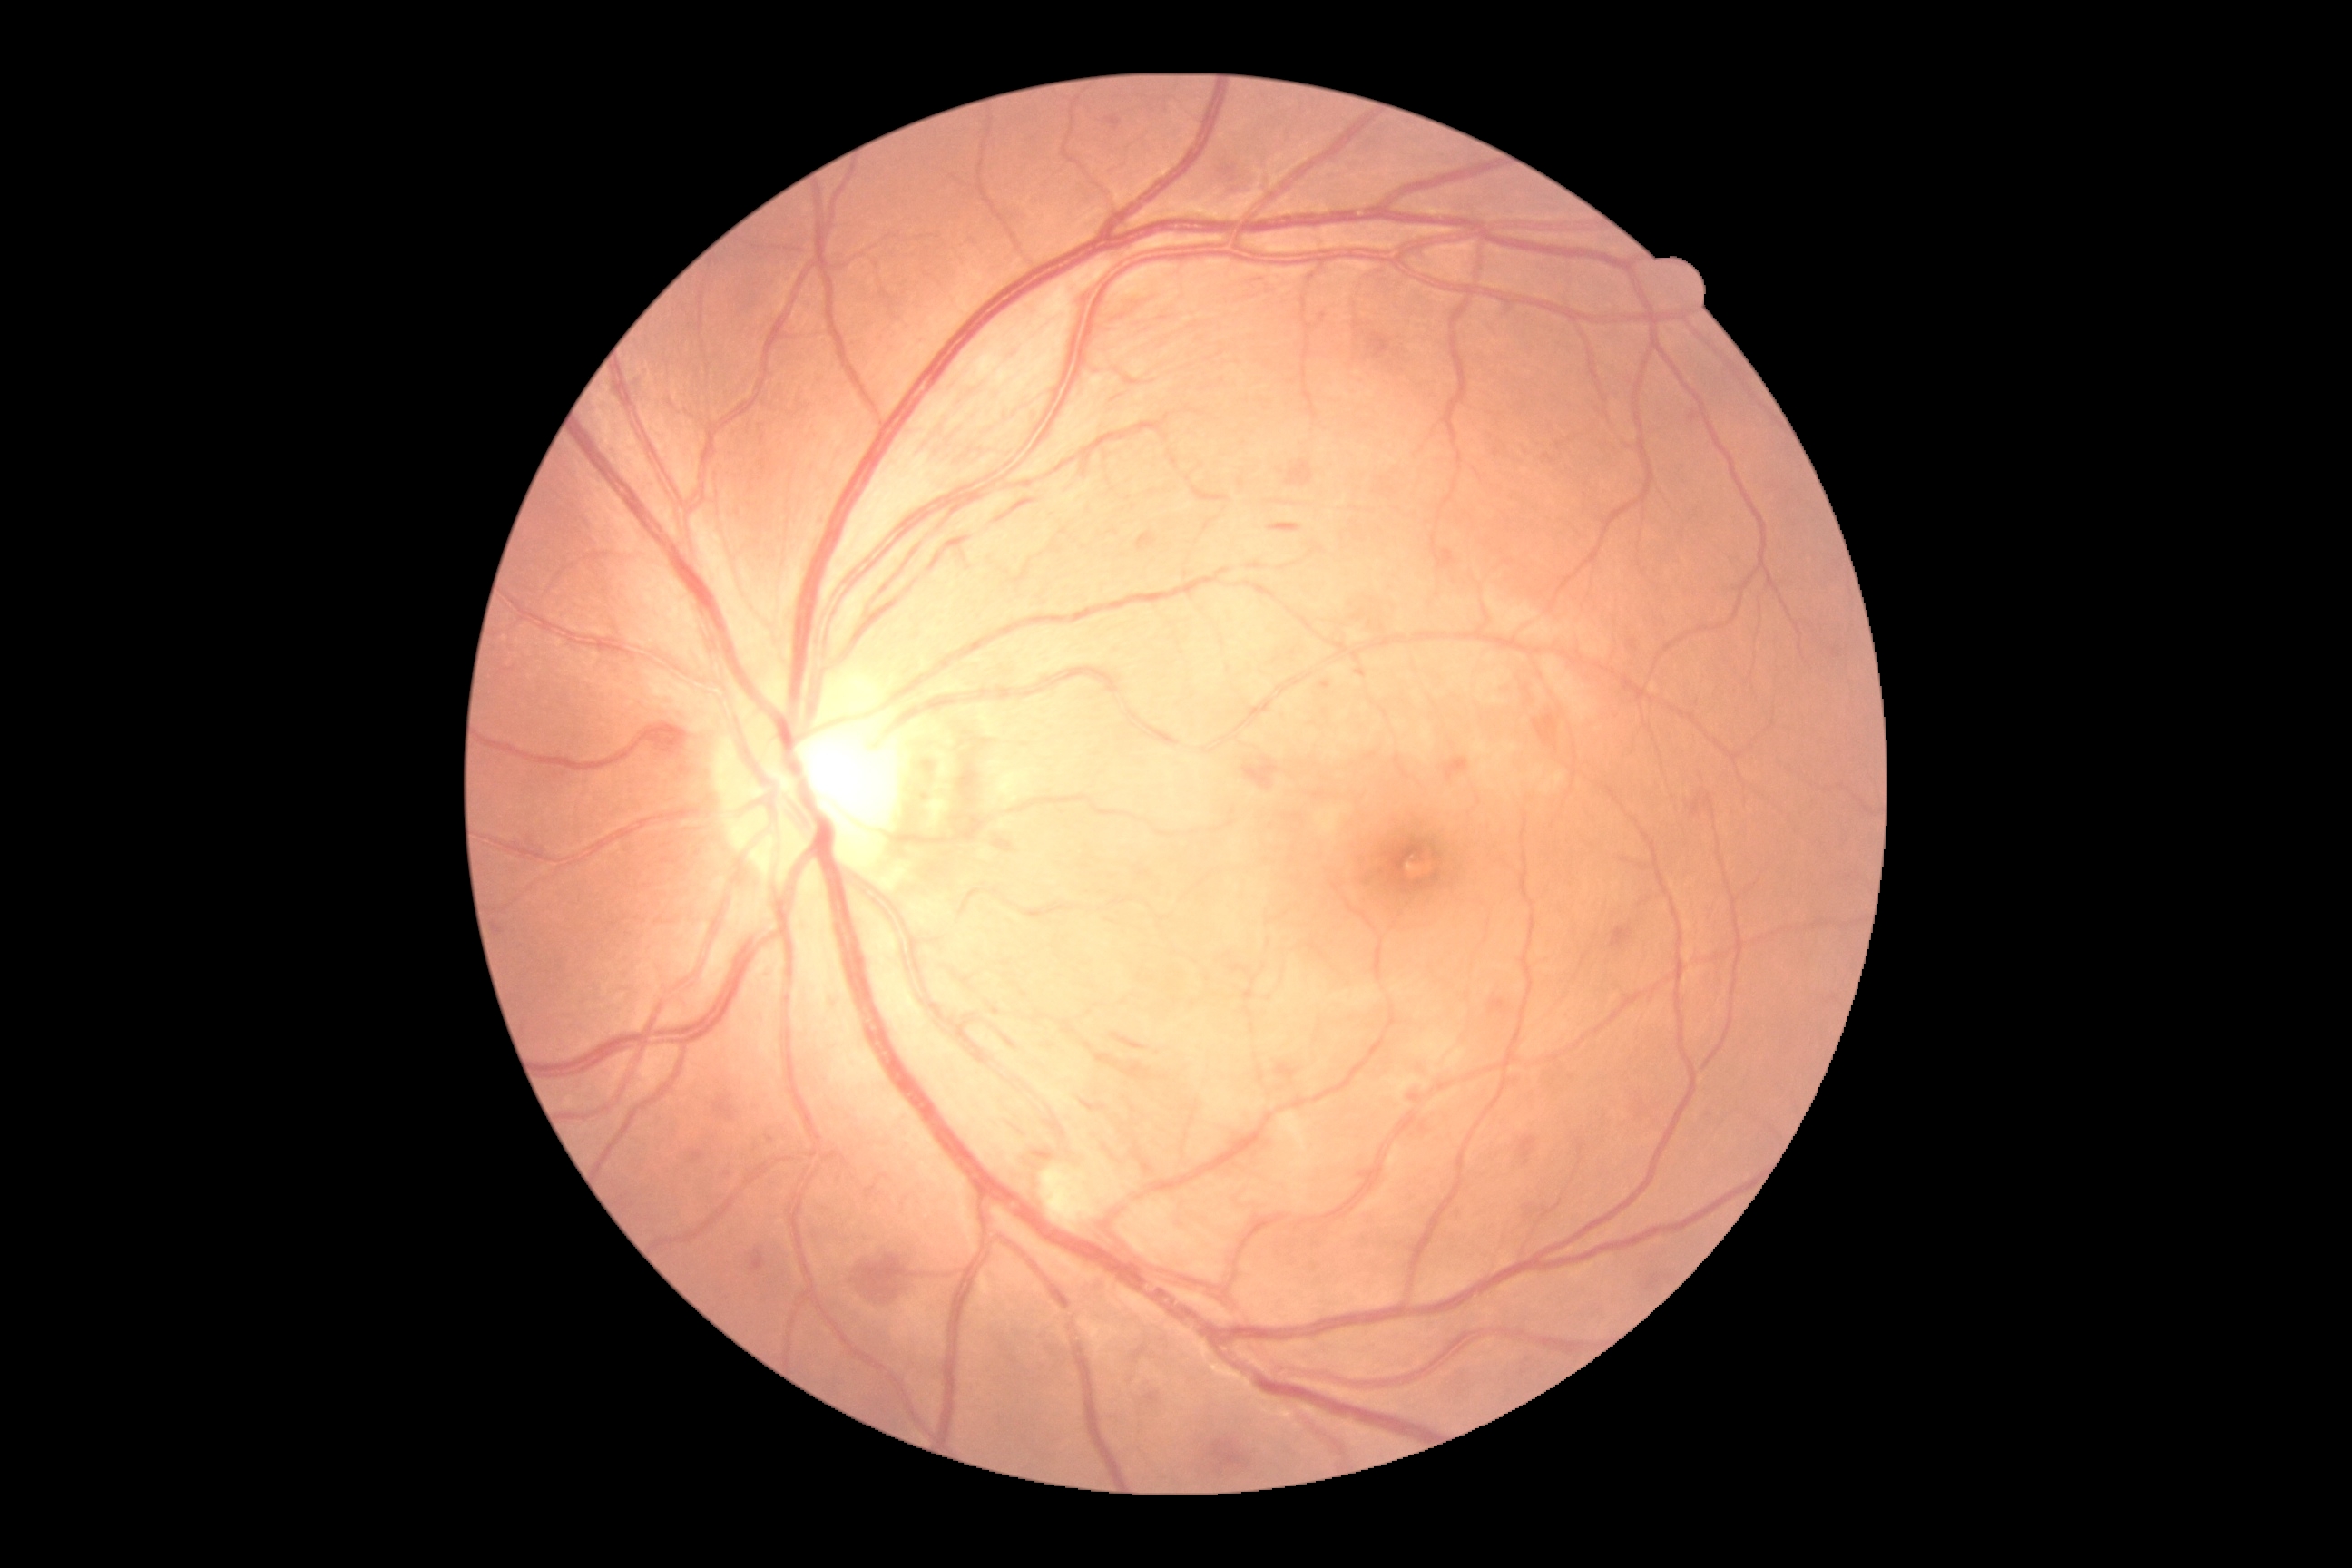 Retinopathy grade is 2 (moderate NPDR).